Wide-field retinal mosaic image: 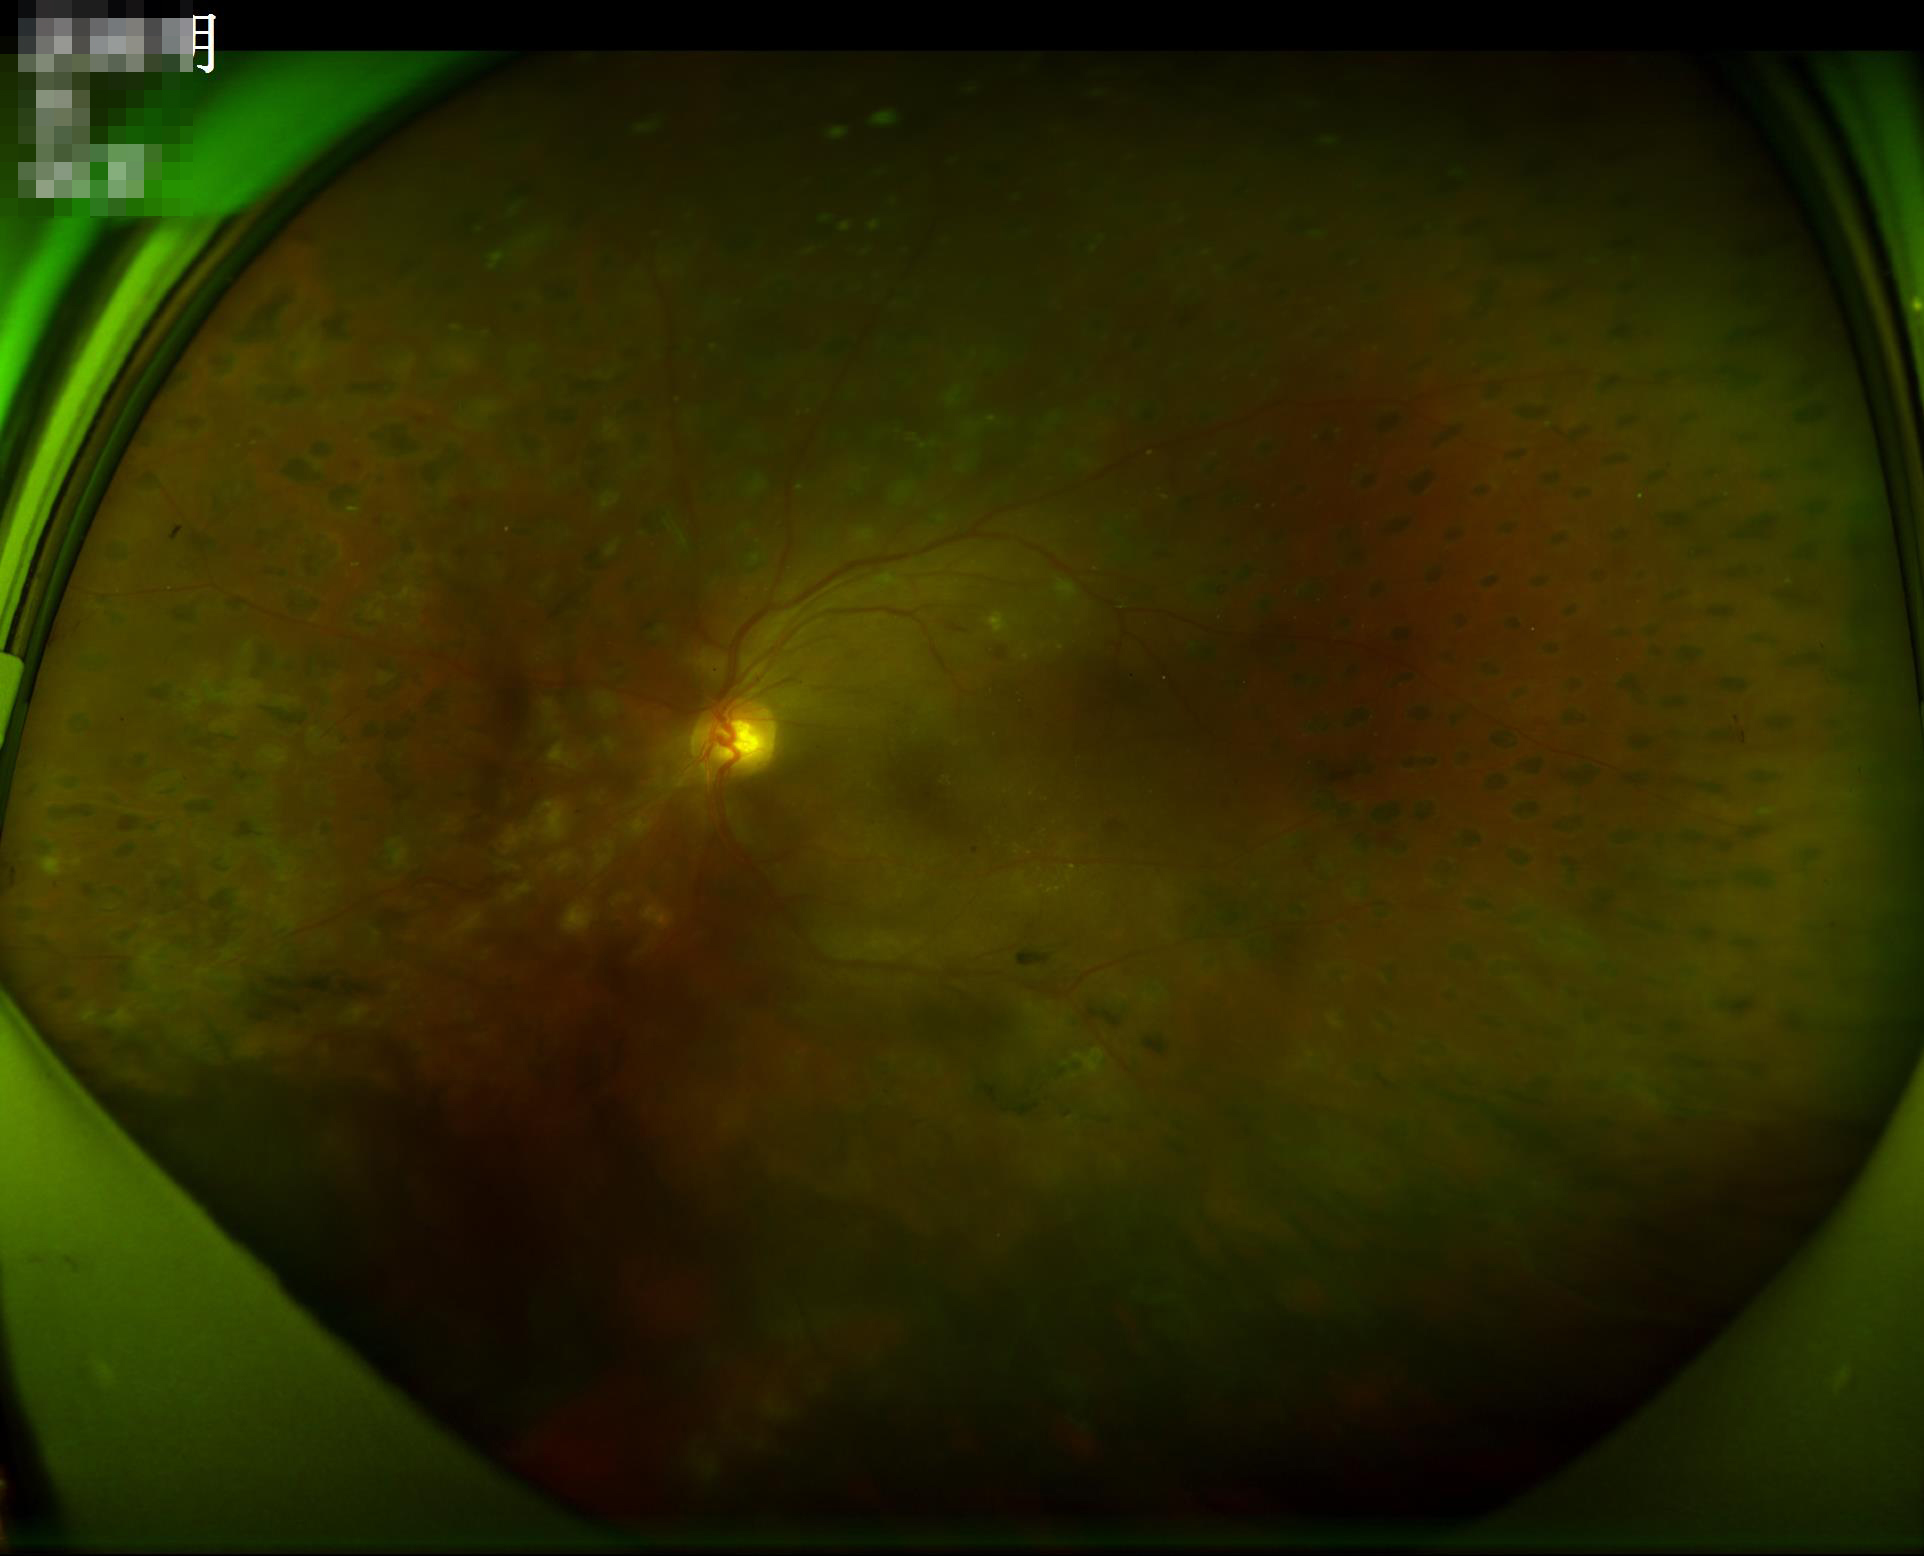
Acceptable image quality.
Adequate contrast for distinguishing structures.
Illumination and color are suboptimal.